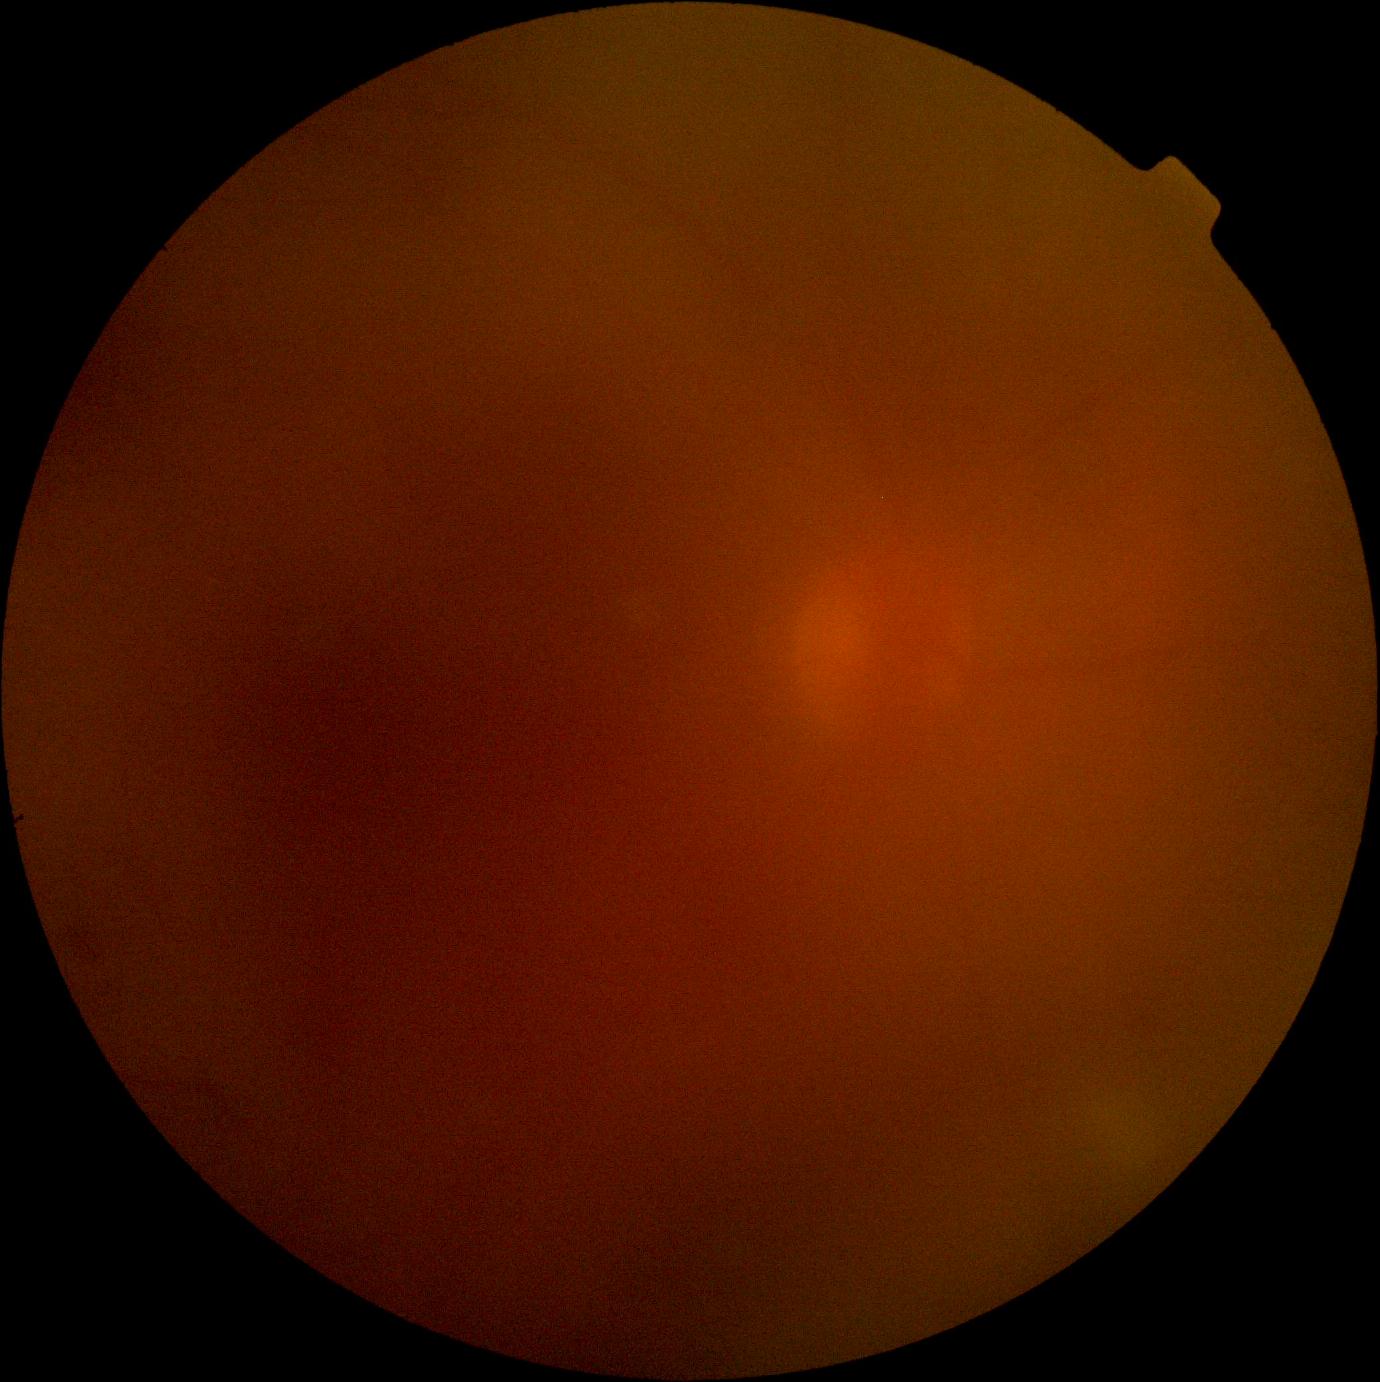

Retinopathy grade is ungradable.